Disc-centered field, 240x240px — 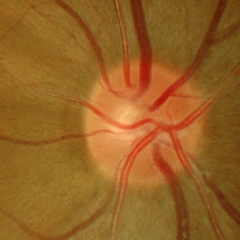
Assessment = early glaucoma. (Criteria: glaucomatous retinal nerve fiber layer defects on red-free fundus photography without visual field defects.)